Natus RetCam Envision, 130° FOV. Wide-field fundus photograph from neonatal ROP screening — 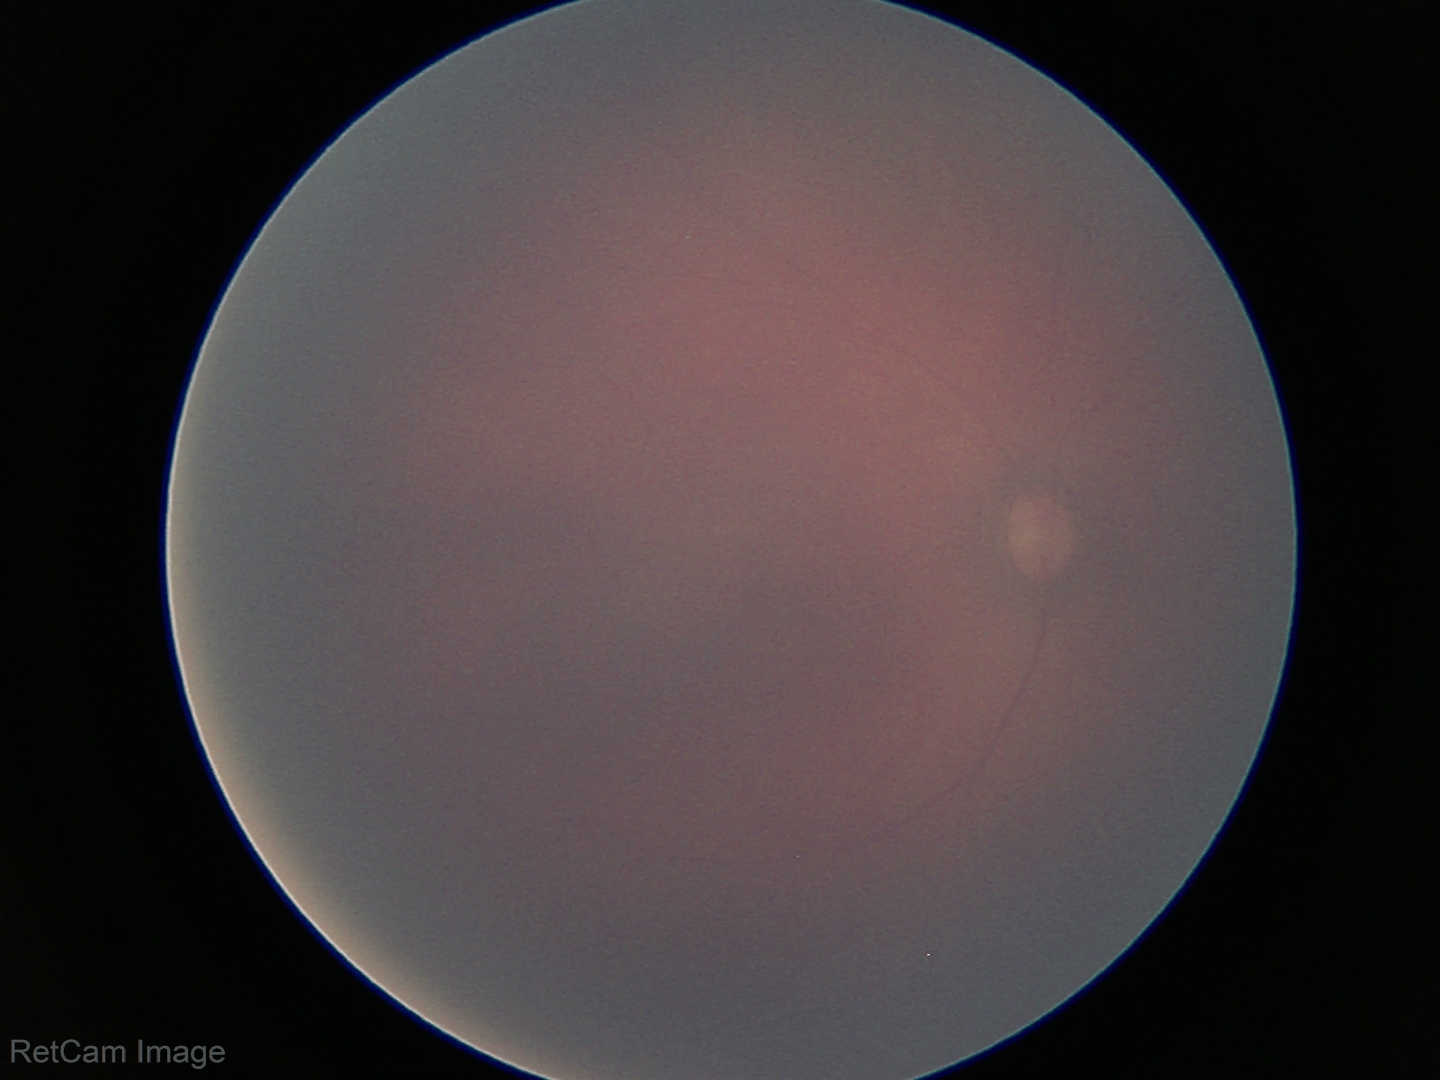 Q: What is the screening diagnosis?
A: normal retinal appearance